Wide-field fundus photograph of an infant — 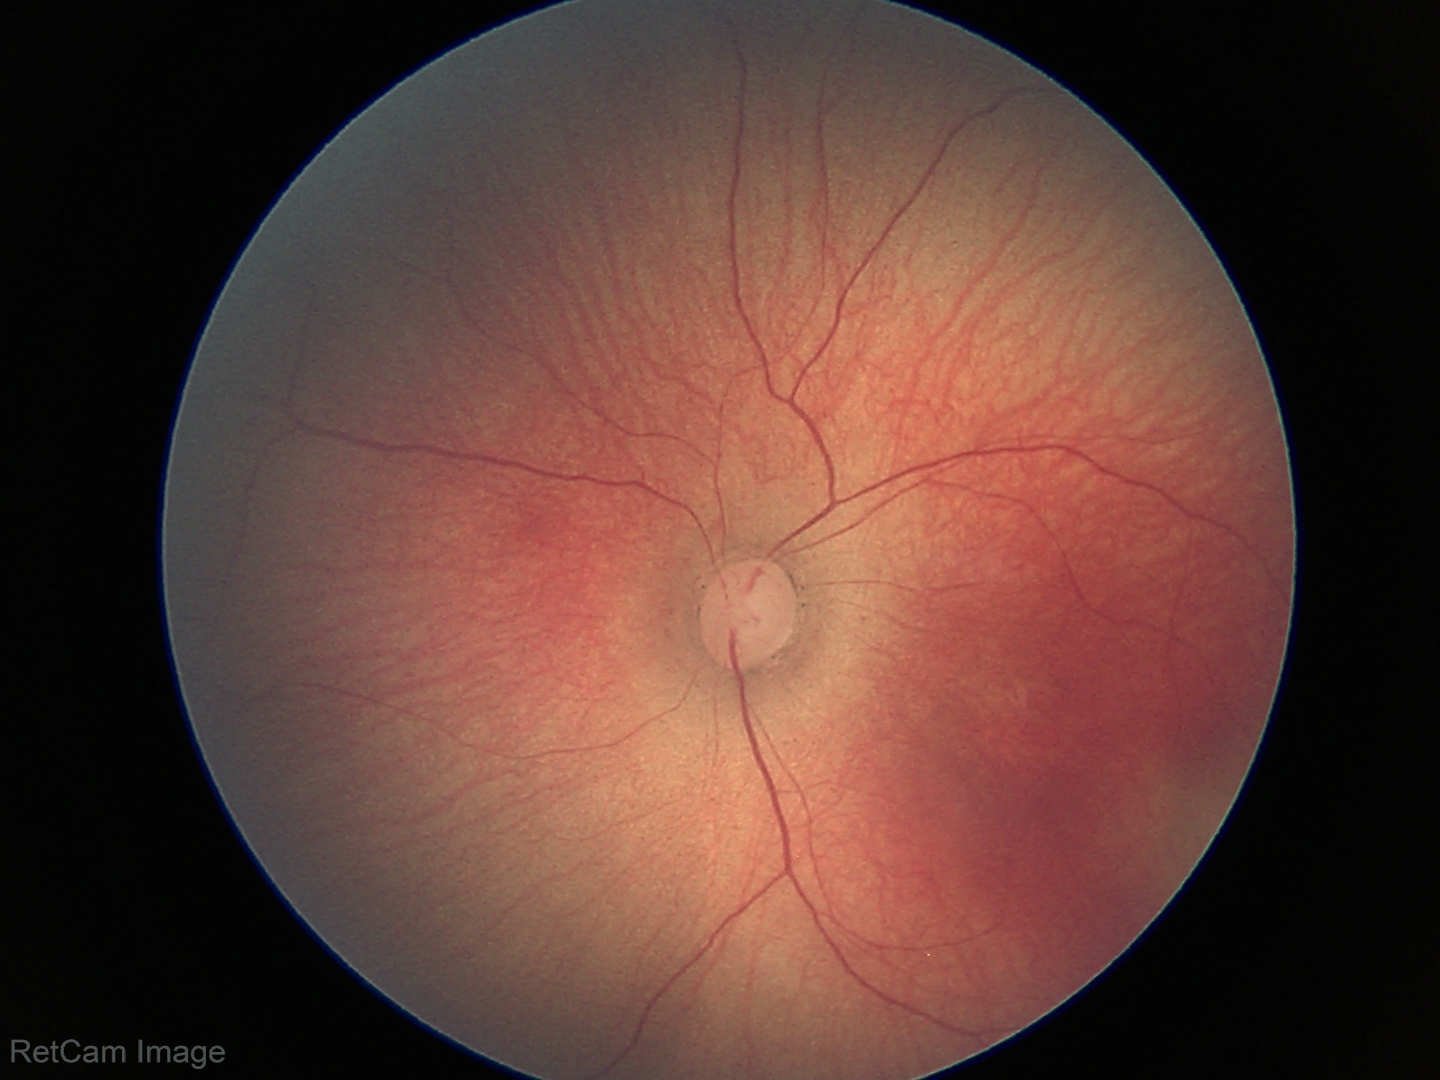

Screening examination consistent with ROP stage 1.
No plus disease.